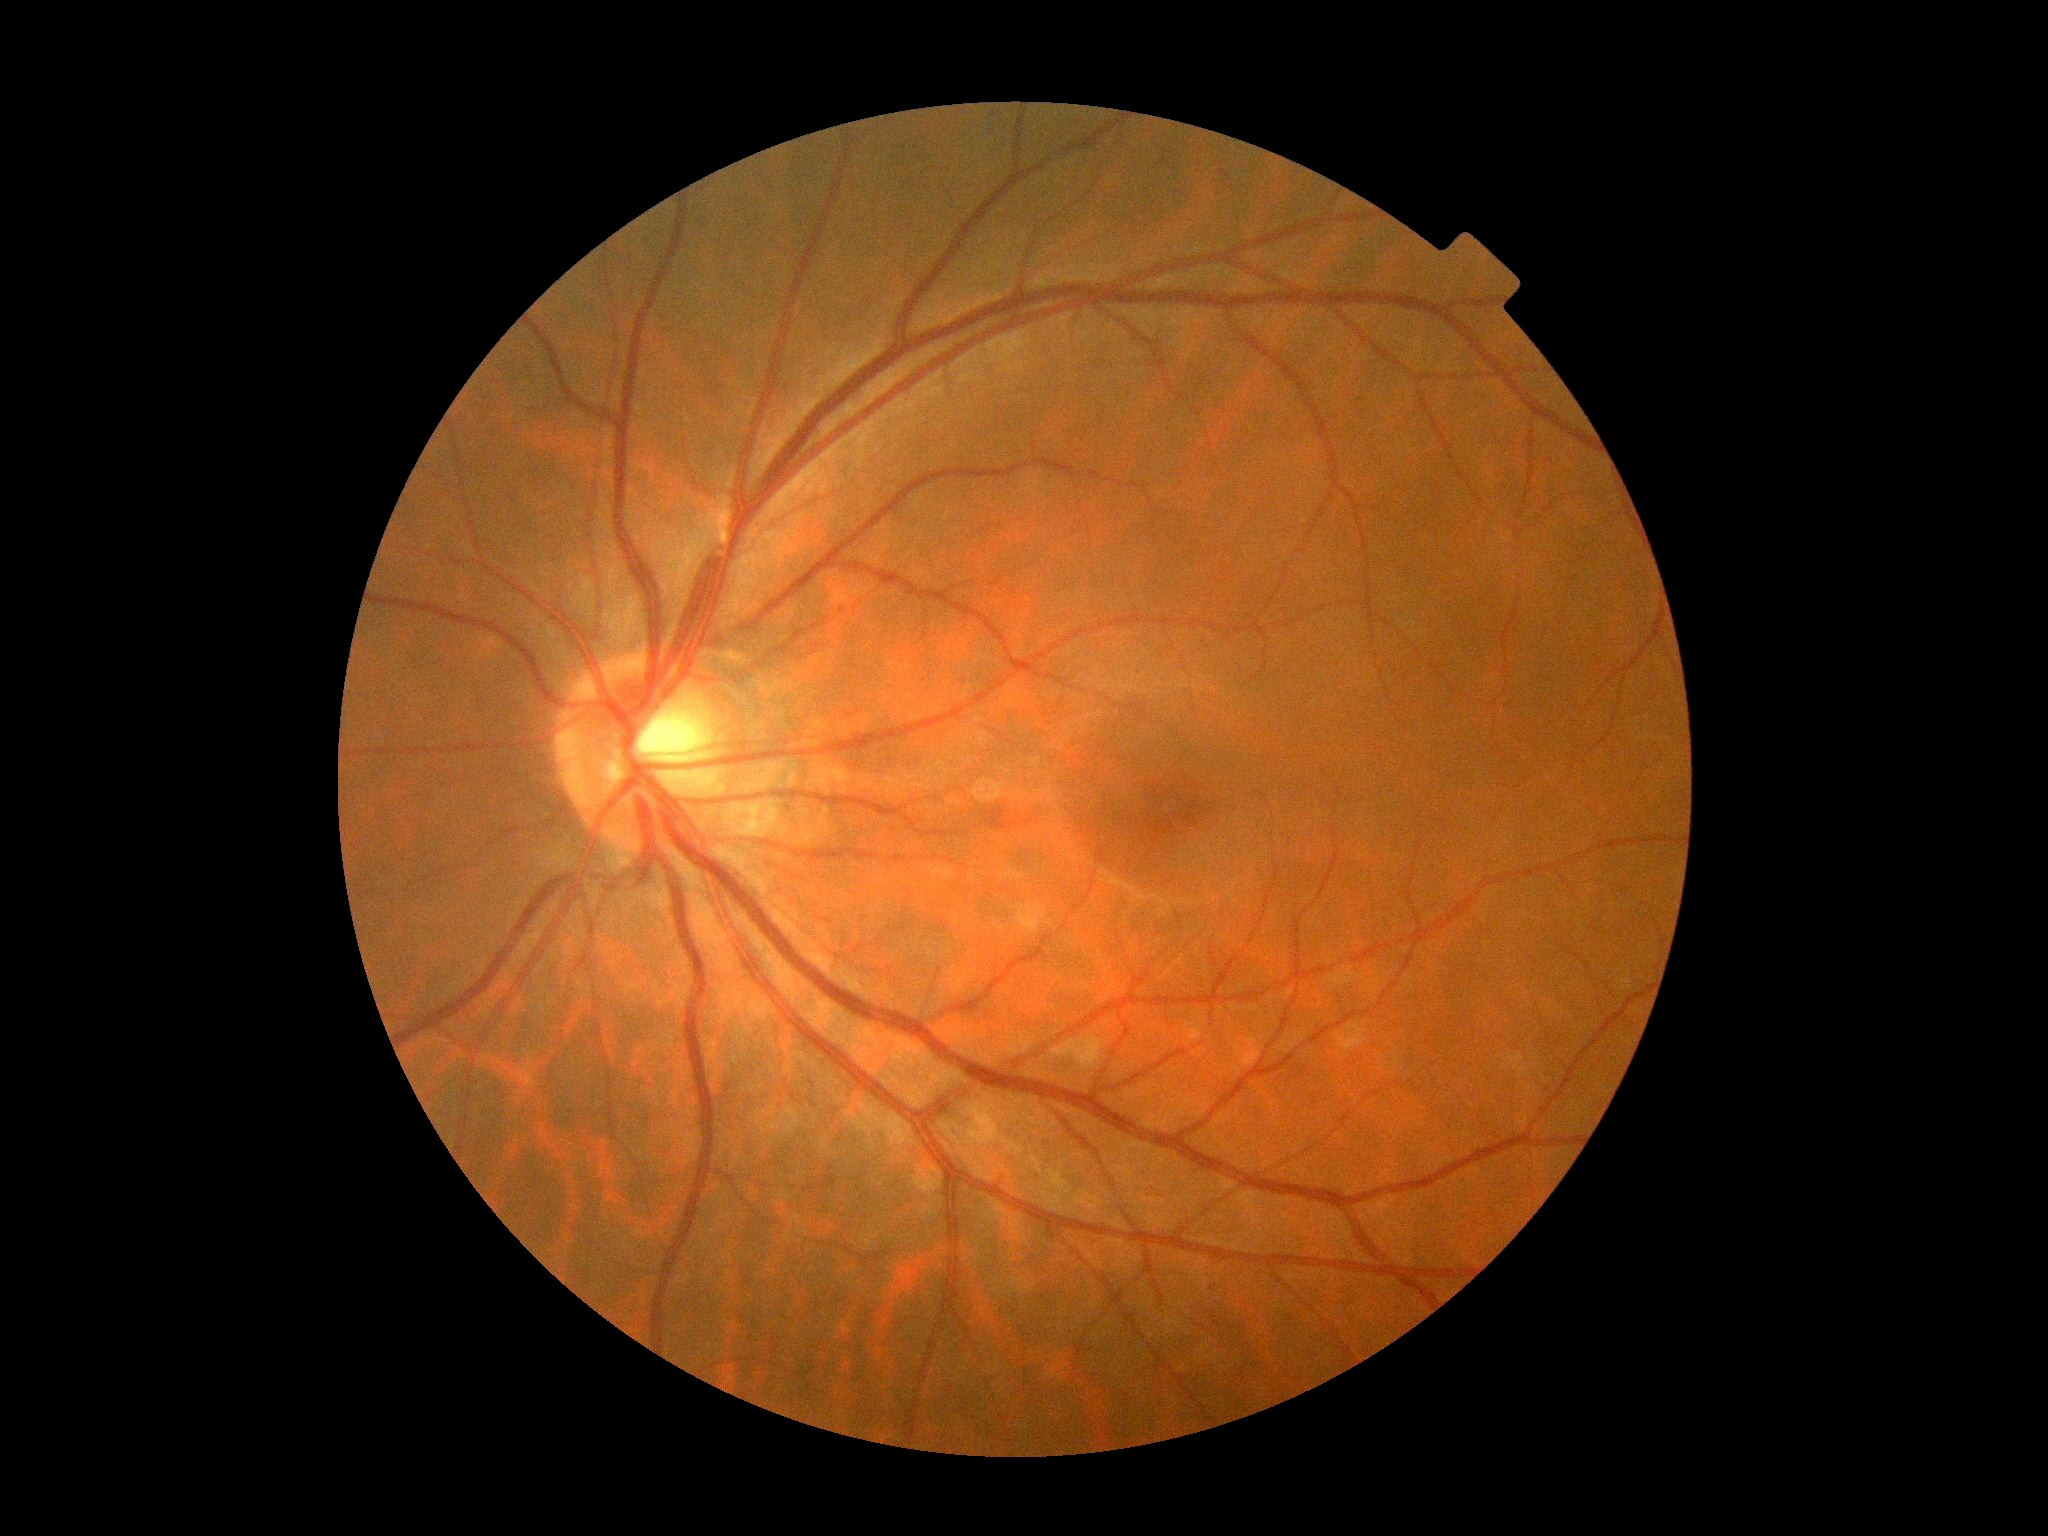

DR impression: no DR findings; DR stage: 0.